Color fundus image; image size 2352x1568
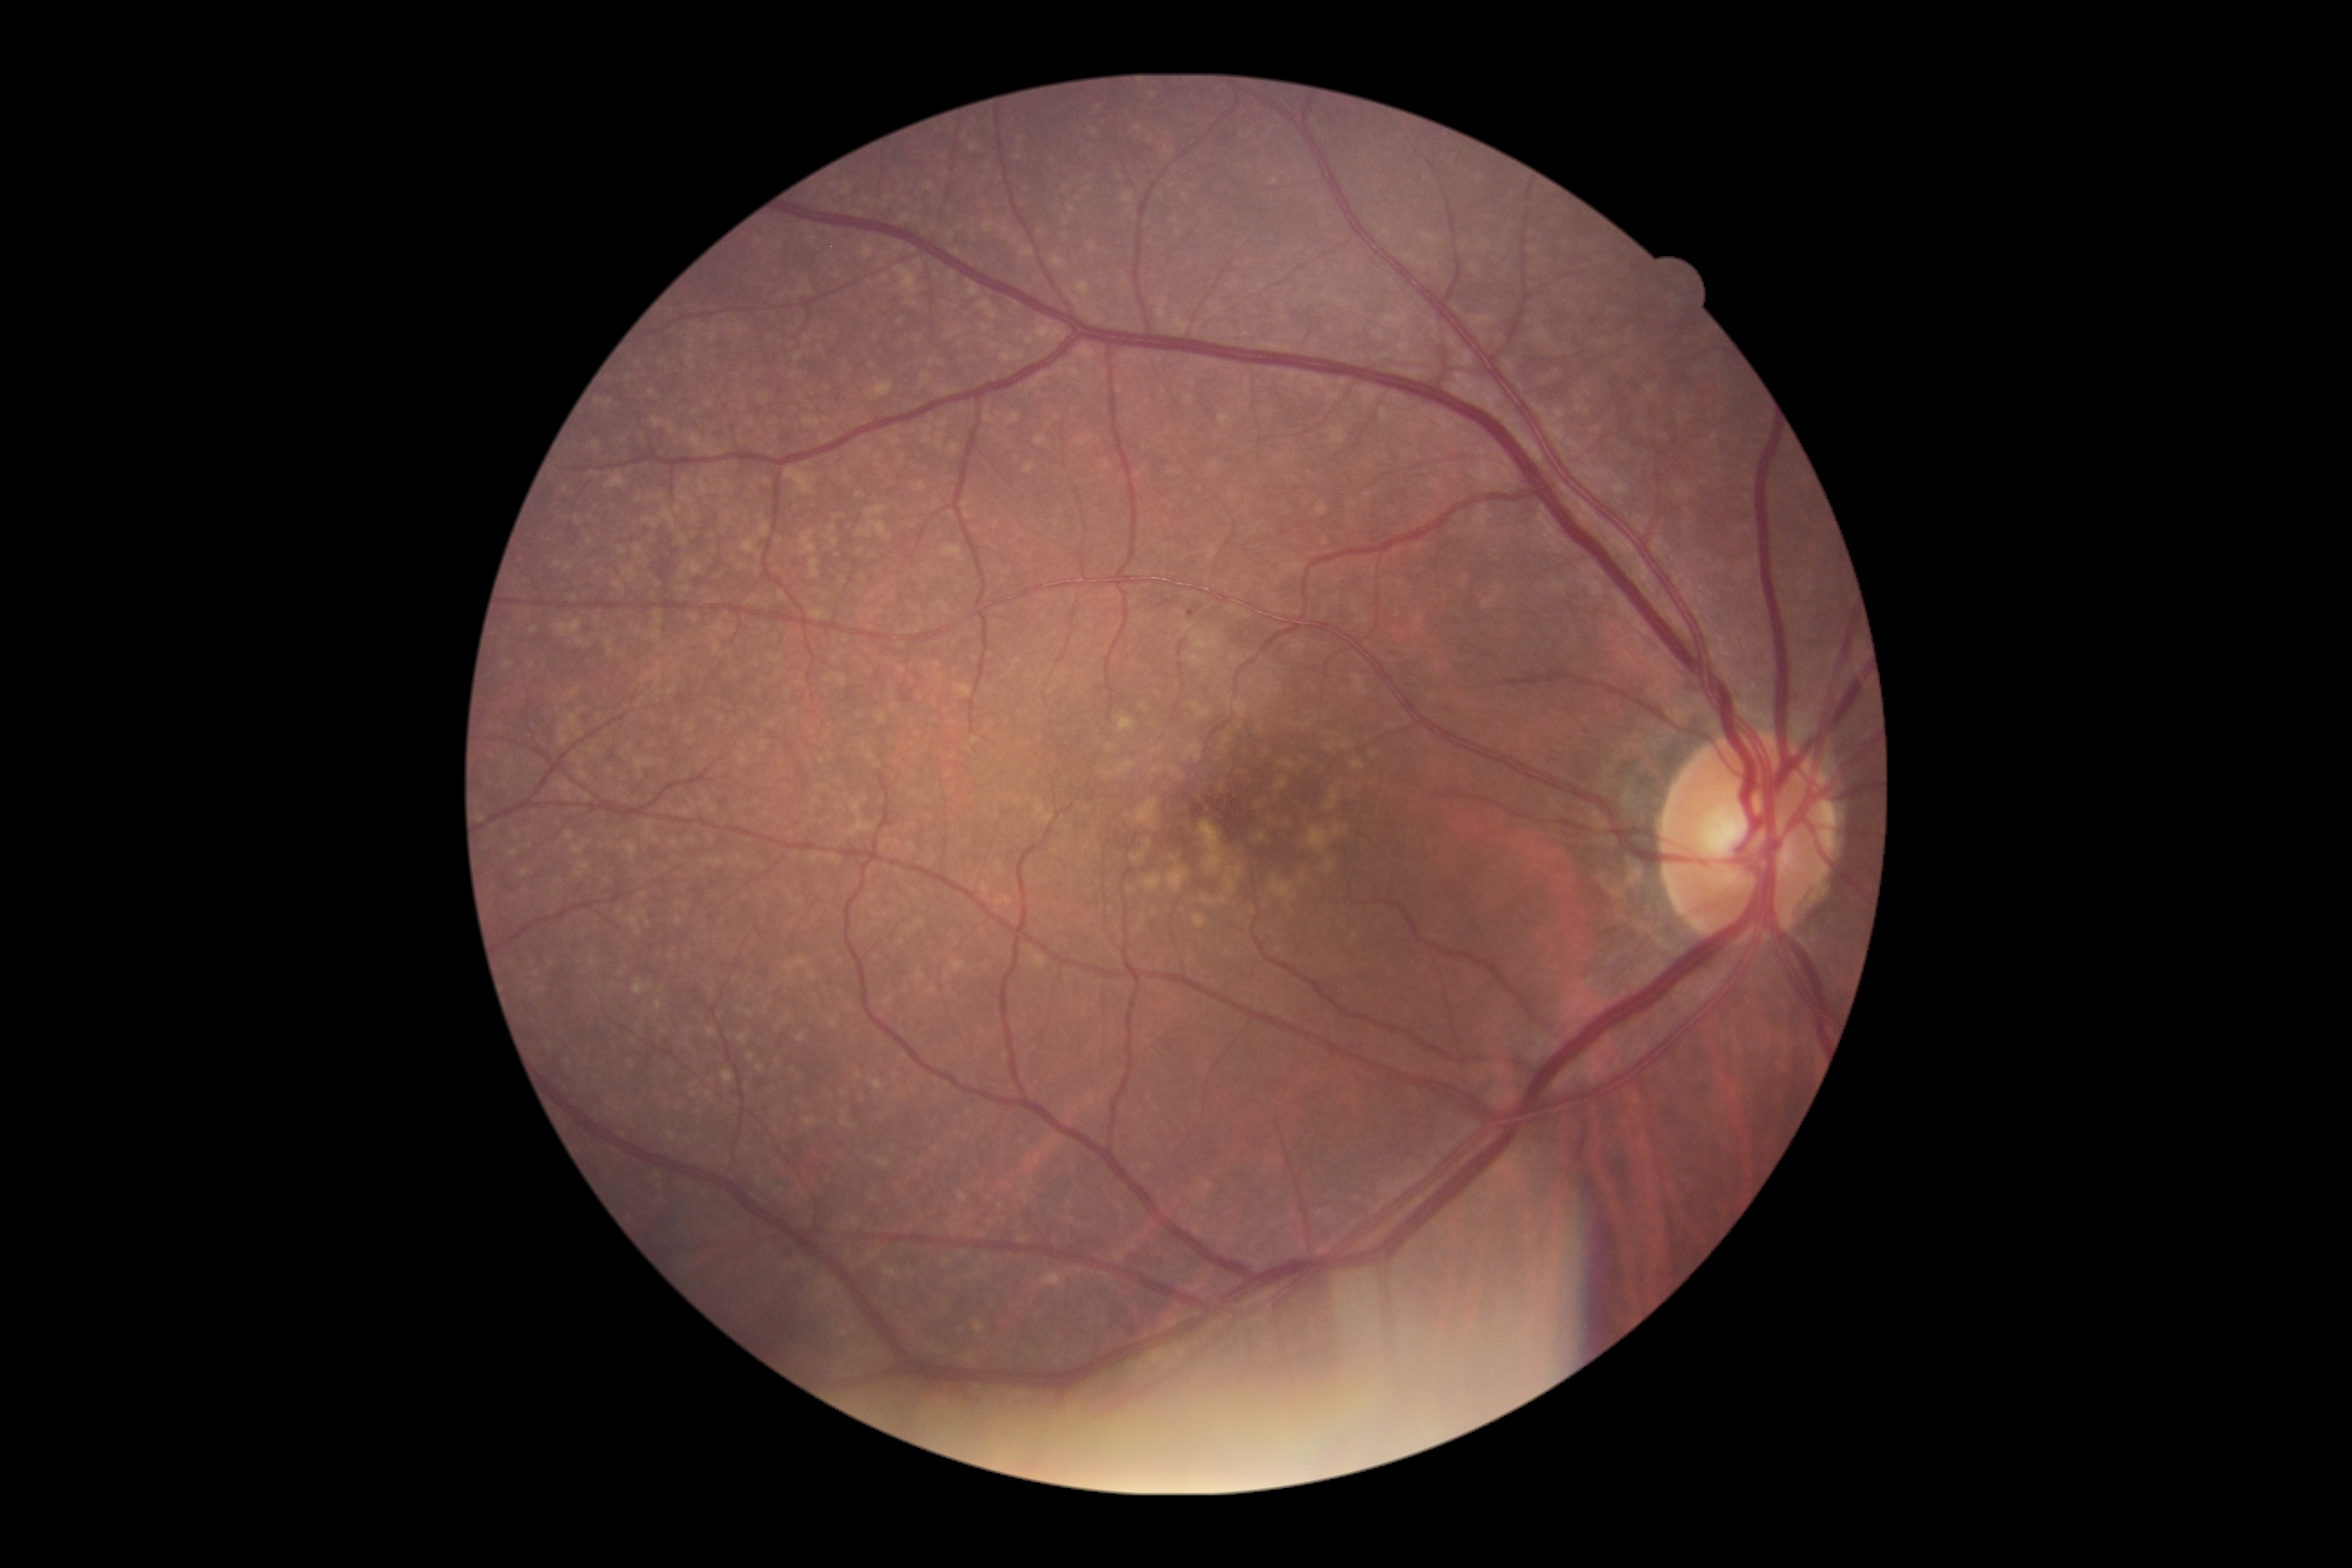
{
  "dr_grade": "mild NPDR (grade 1)"
}